Infant wide-field retinal image. 1240x1240.
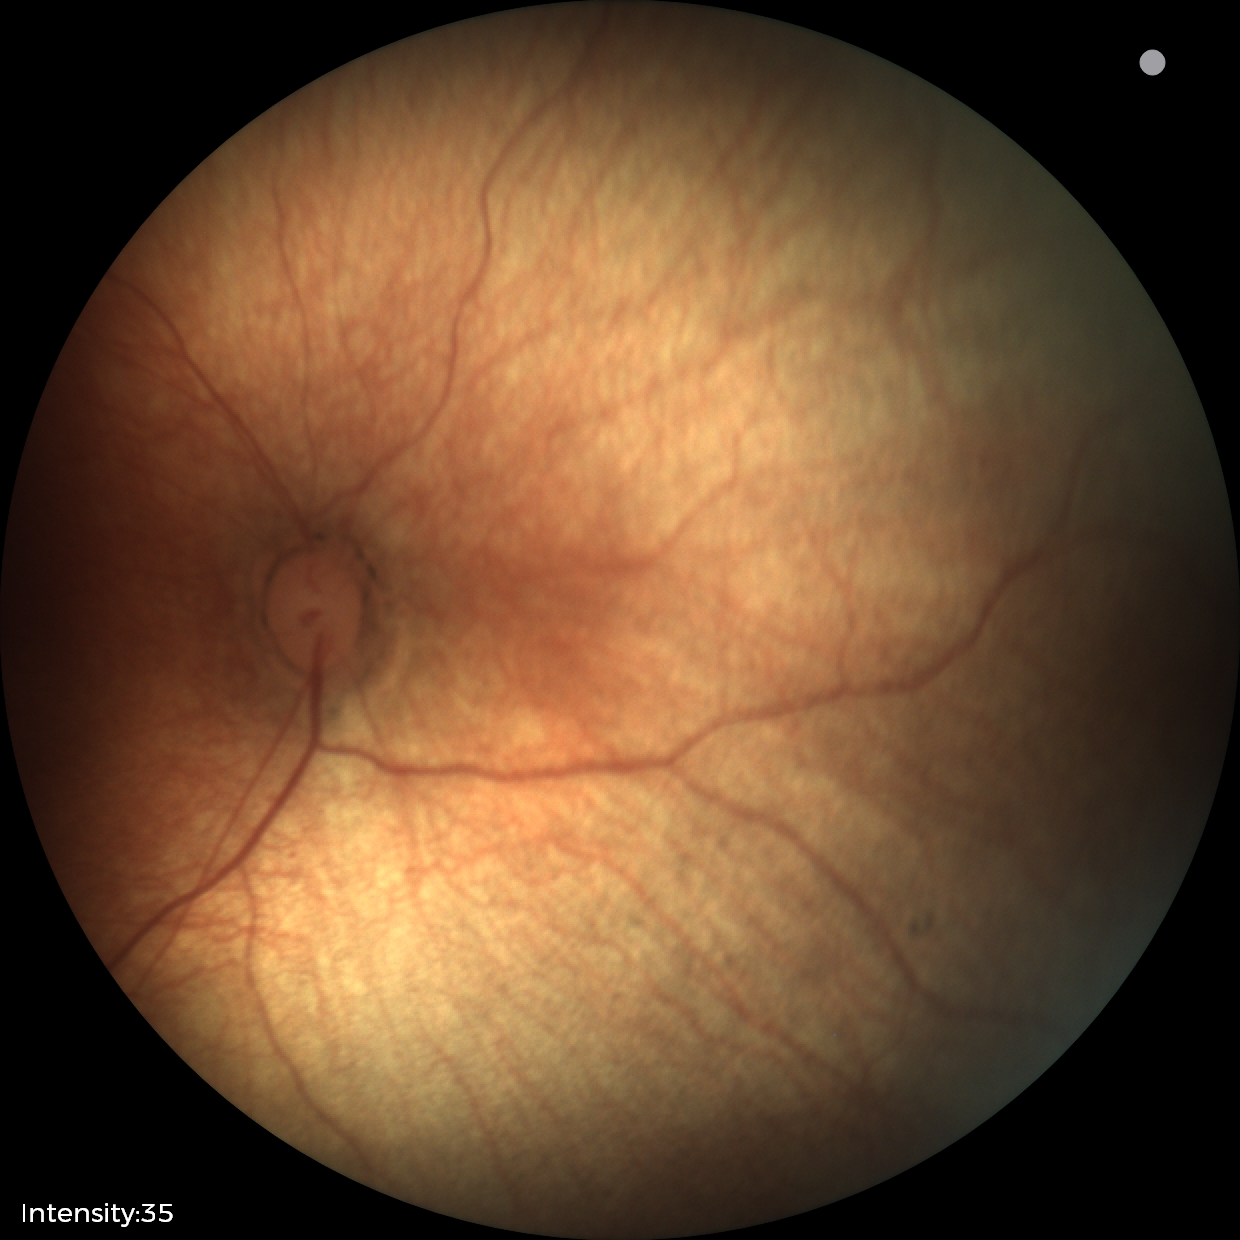

Screening diagnosis: physiological finding.